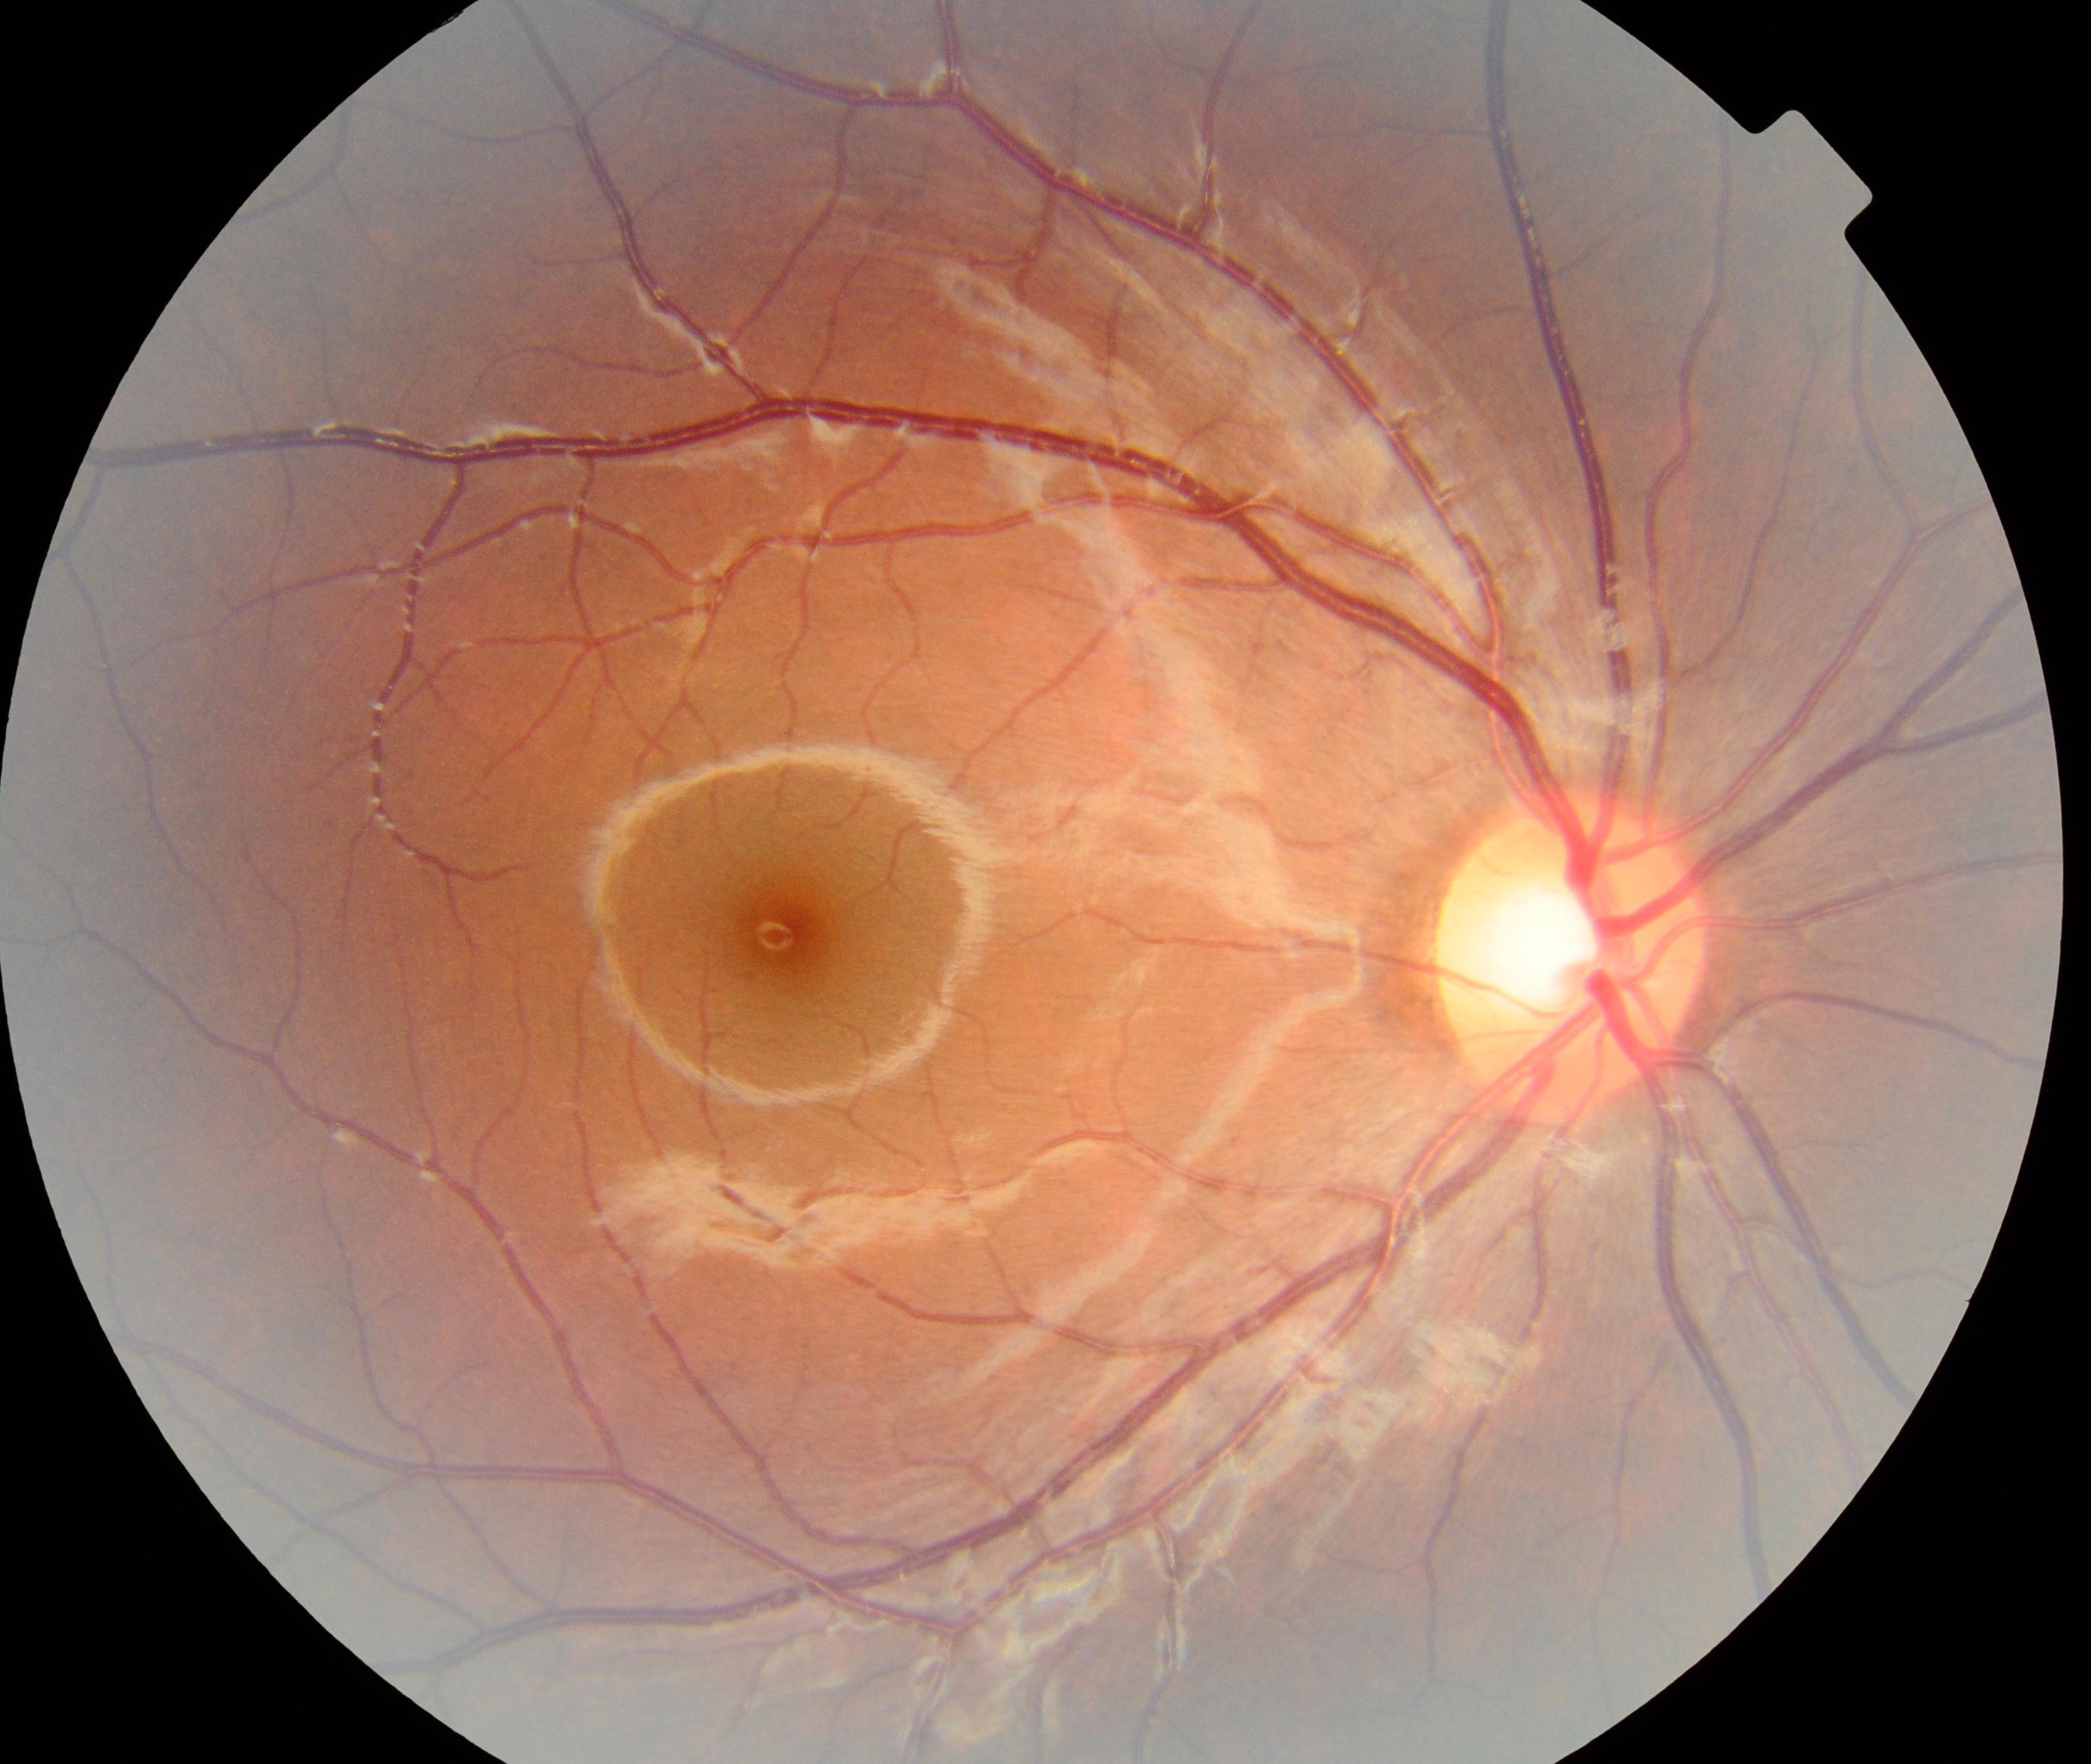
Impression: within normal limits.